Optic nerve head crop; fundus photo; non-mydriatic:
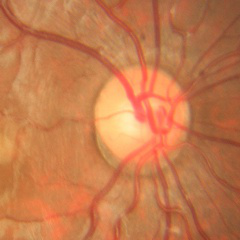 Diagnosis: no glaucoma.